Wide-field fundus photograph of an infant: 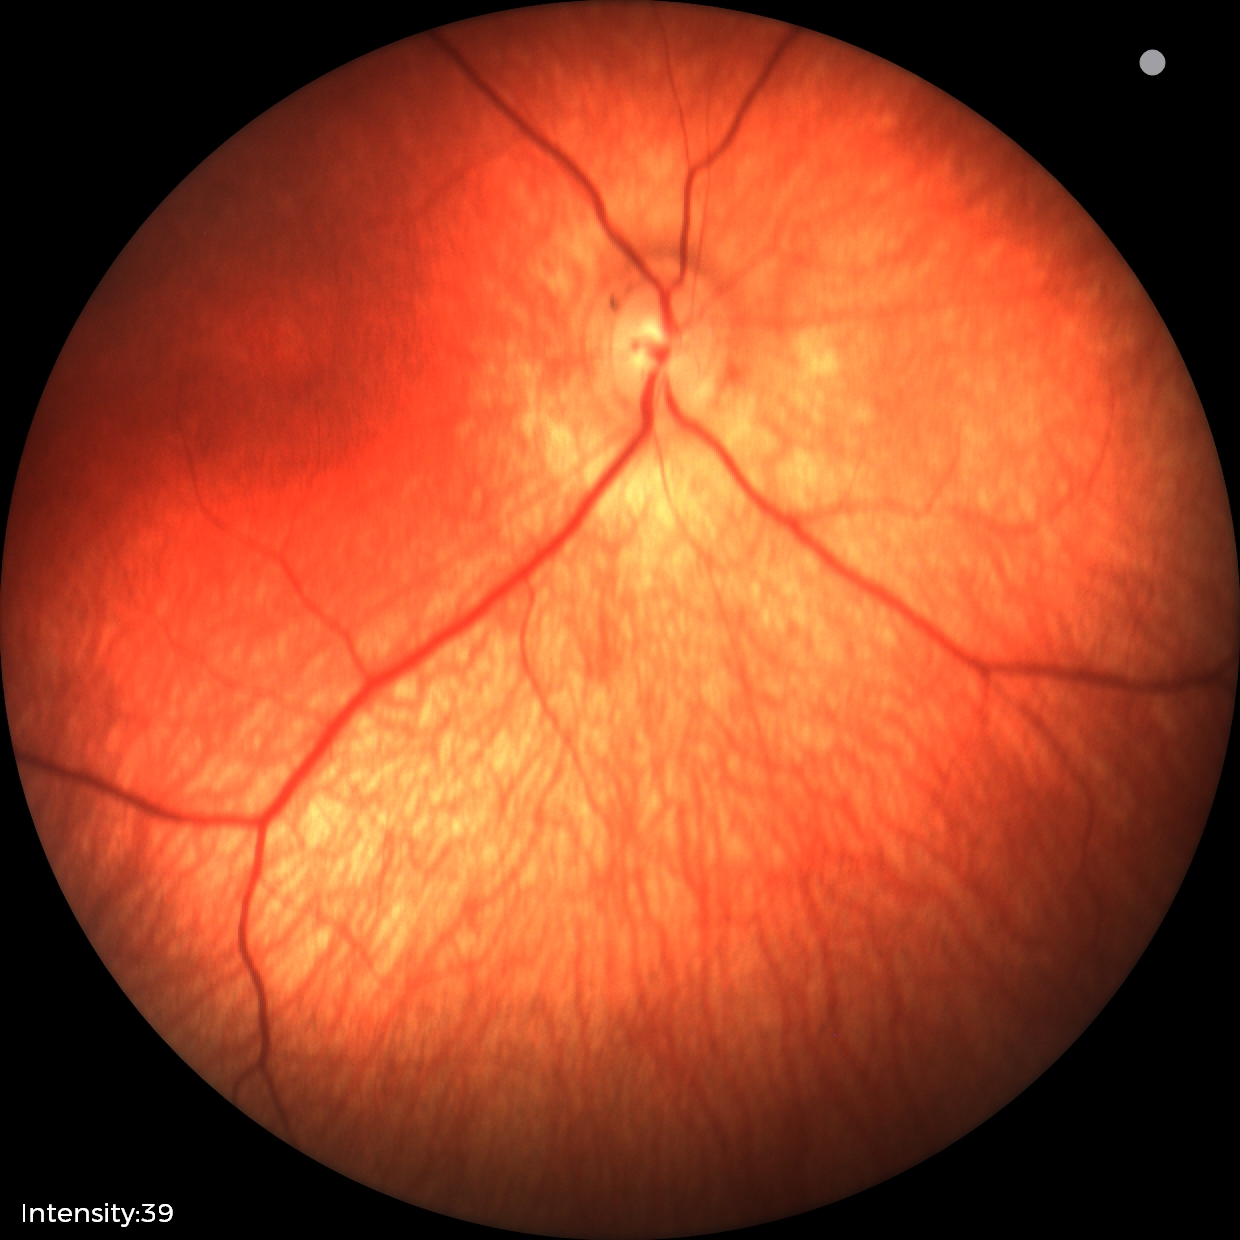
Finding = physiological.